Optic disc-centered crop; captured on a Nidek AFC-330 fundus camera; image size 240x240.
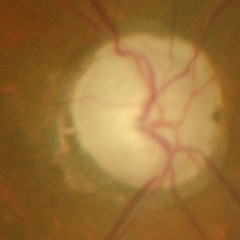

Optic disc photograph demonstrating advanced glaucomatous optic neuropathy.